2352 x 1568 pixels: 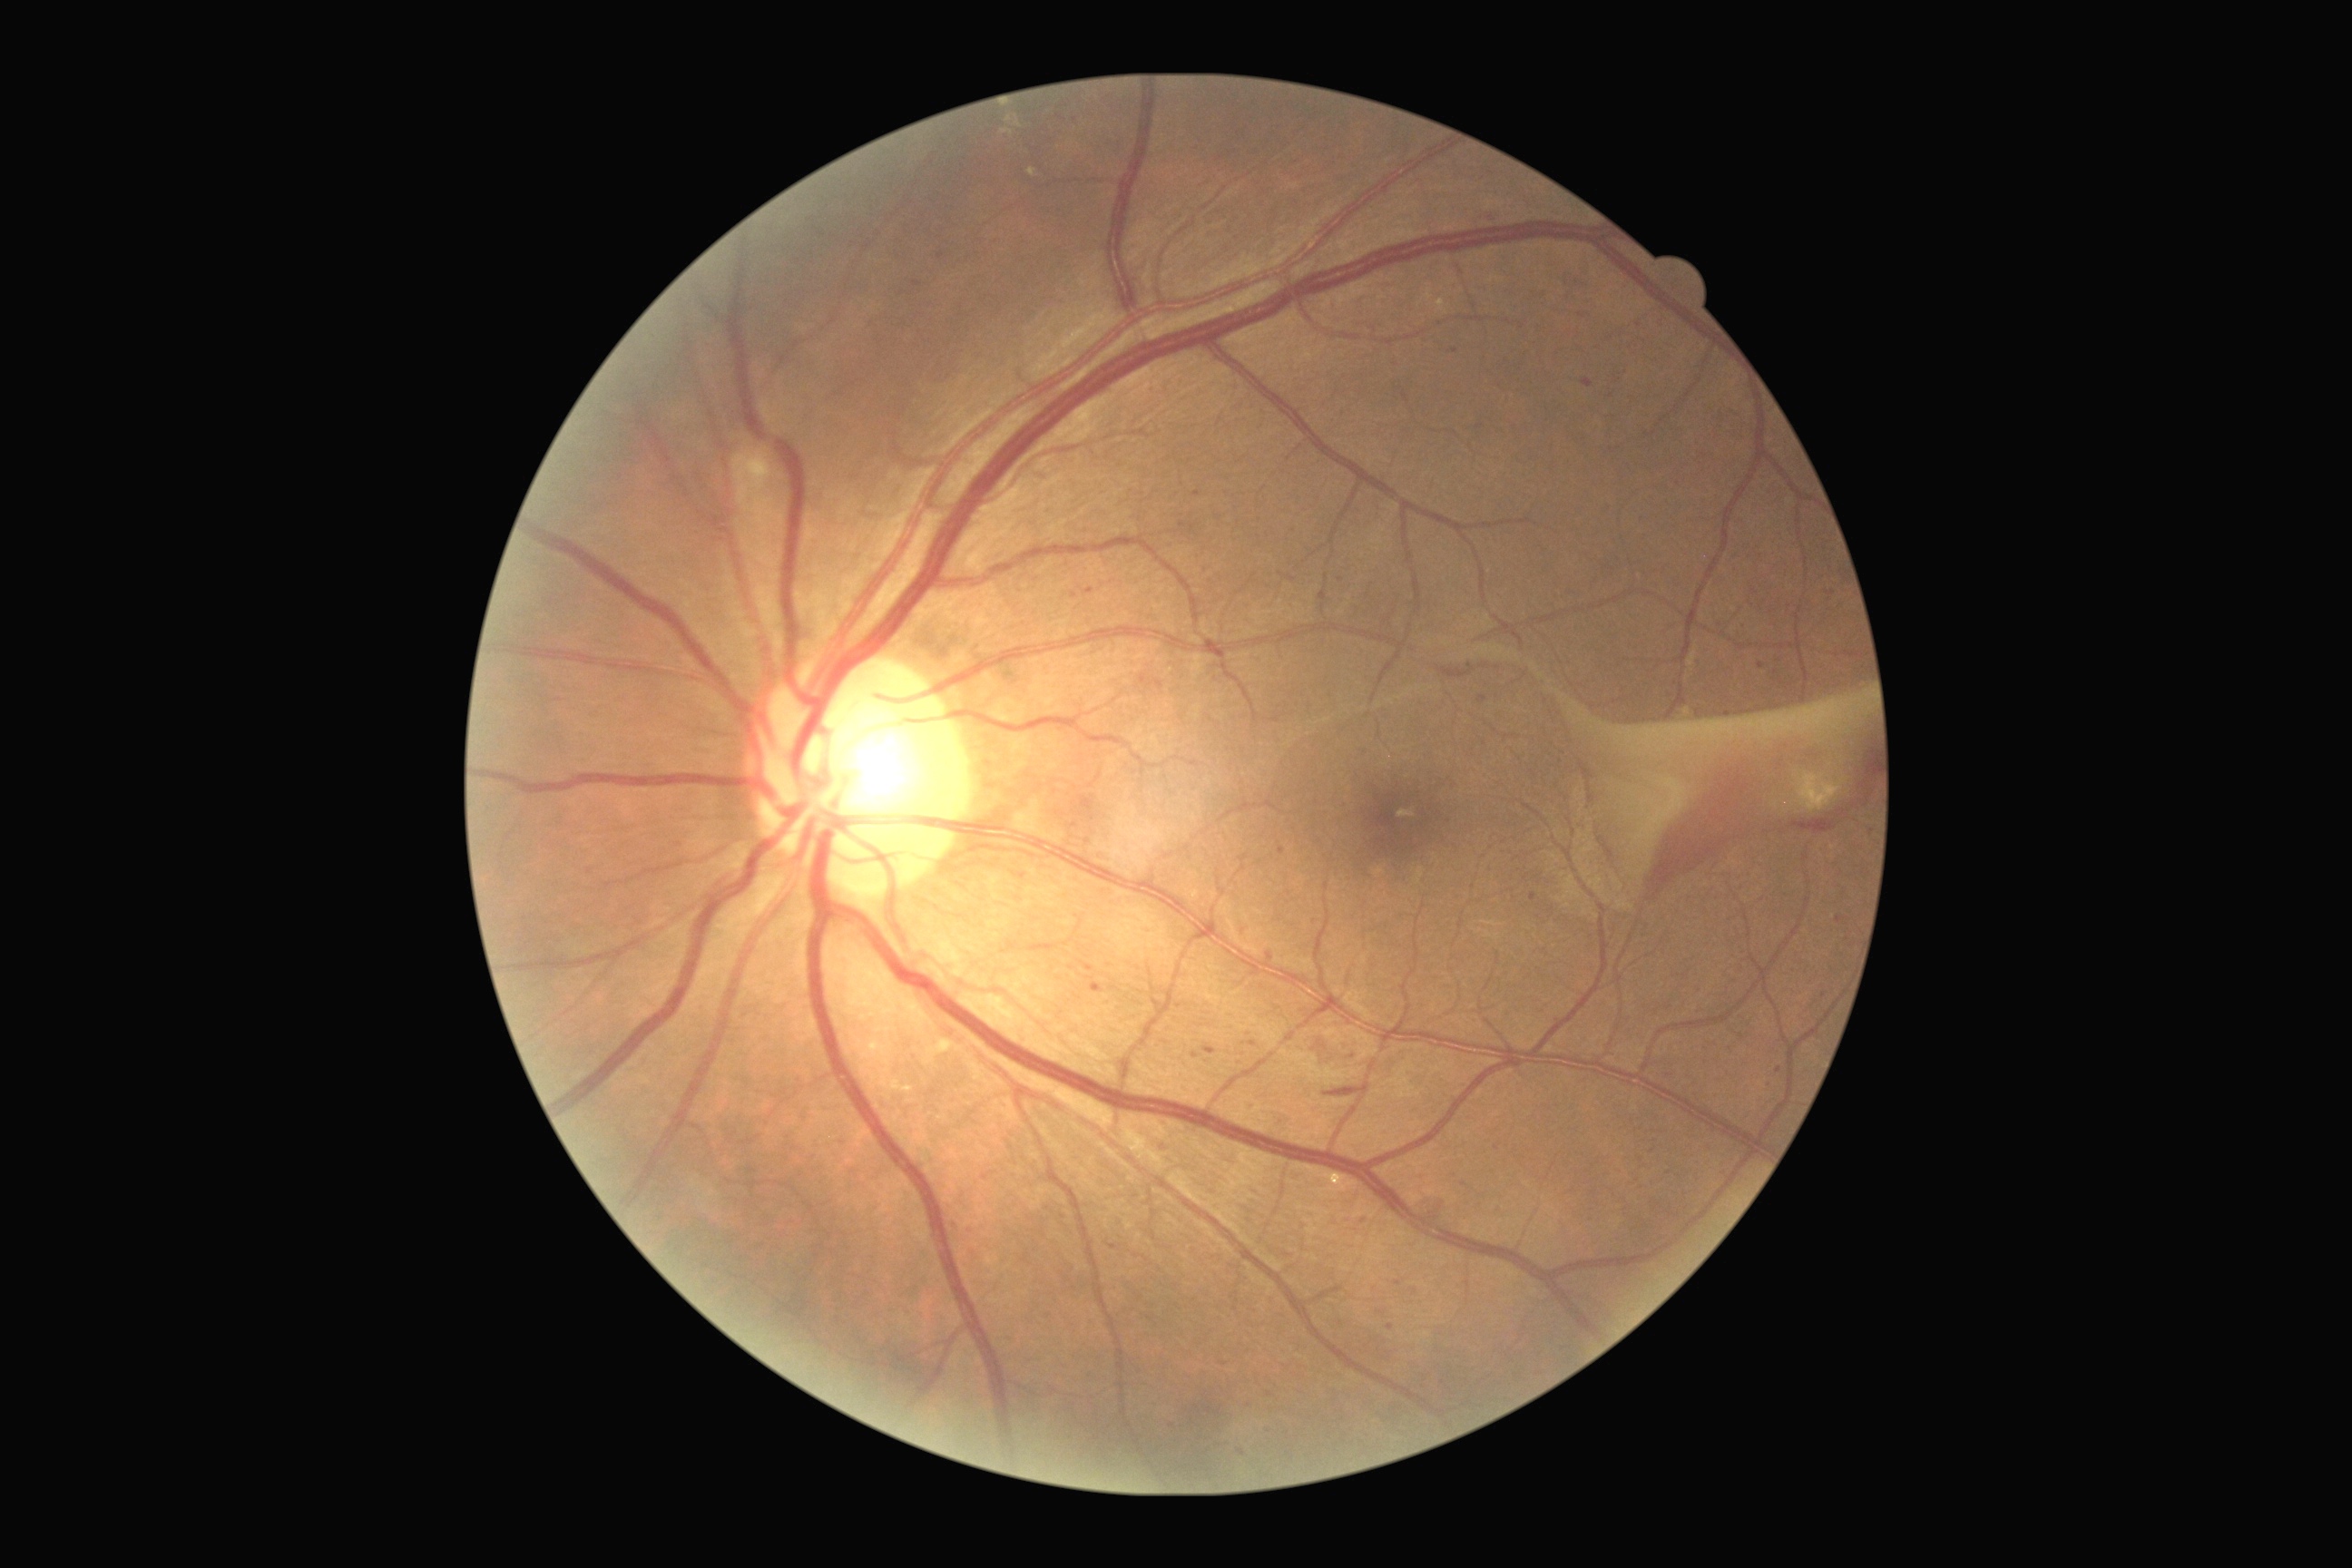 Retinopathy: 4.